Graded on the modified Davis scale:
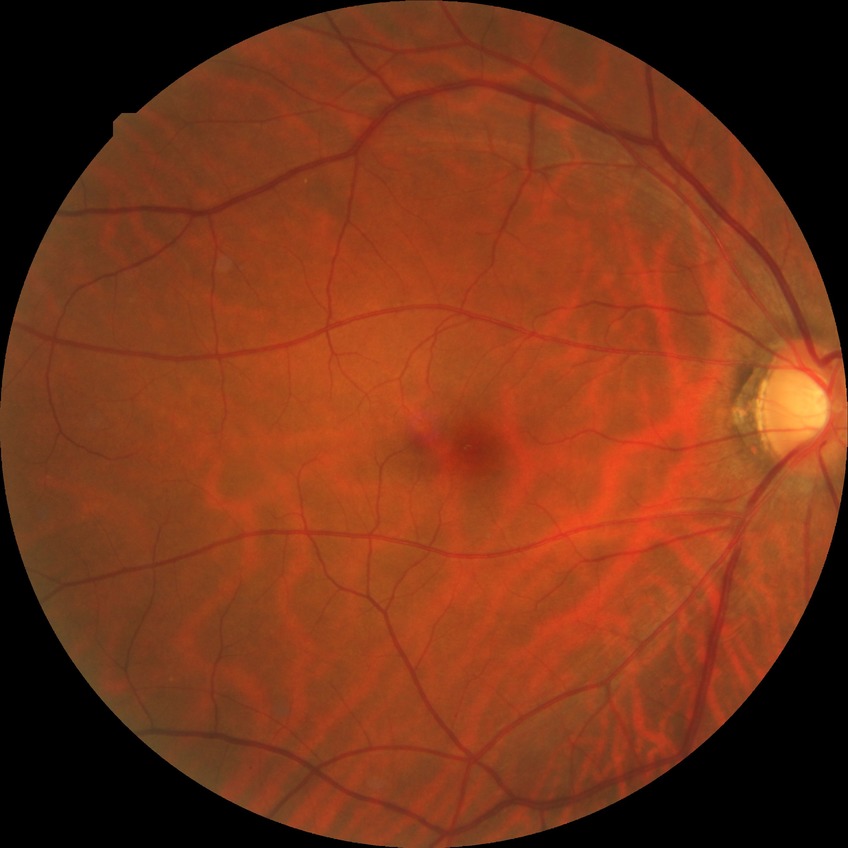
diabetic retinopathy (DR) = NDR (no diabetic retinopathy).